45-degree field of view, 2352 by 1568 pixels
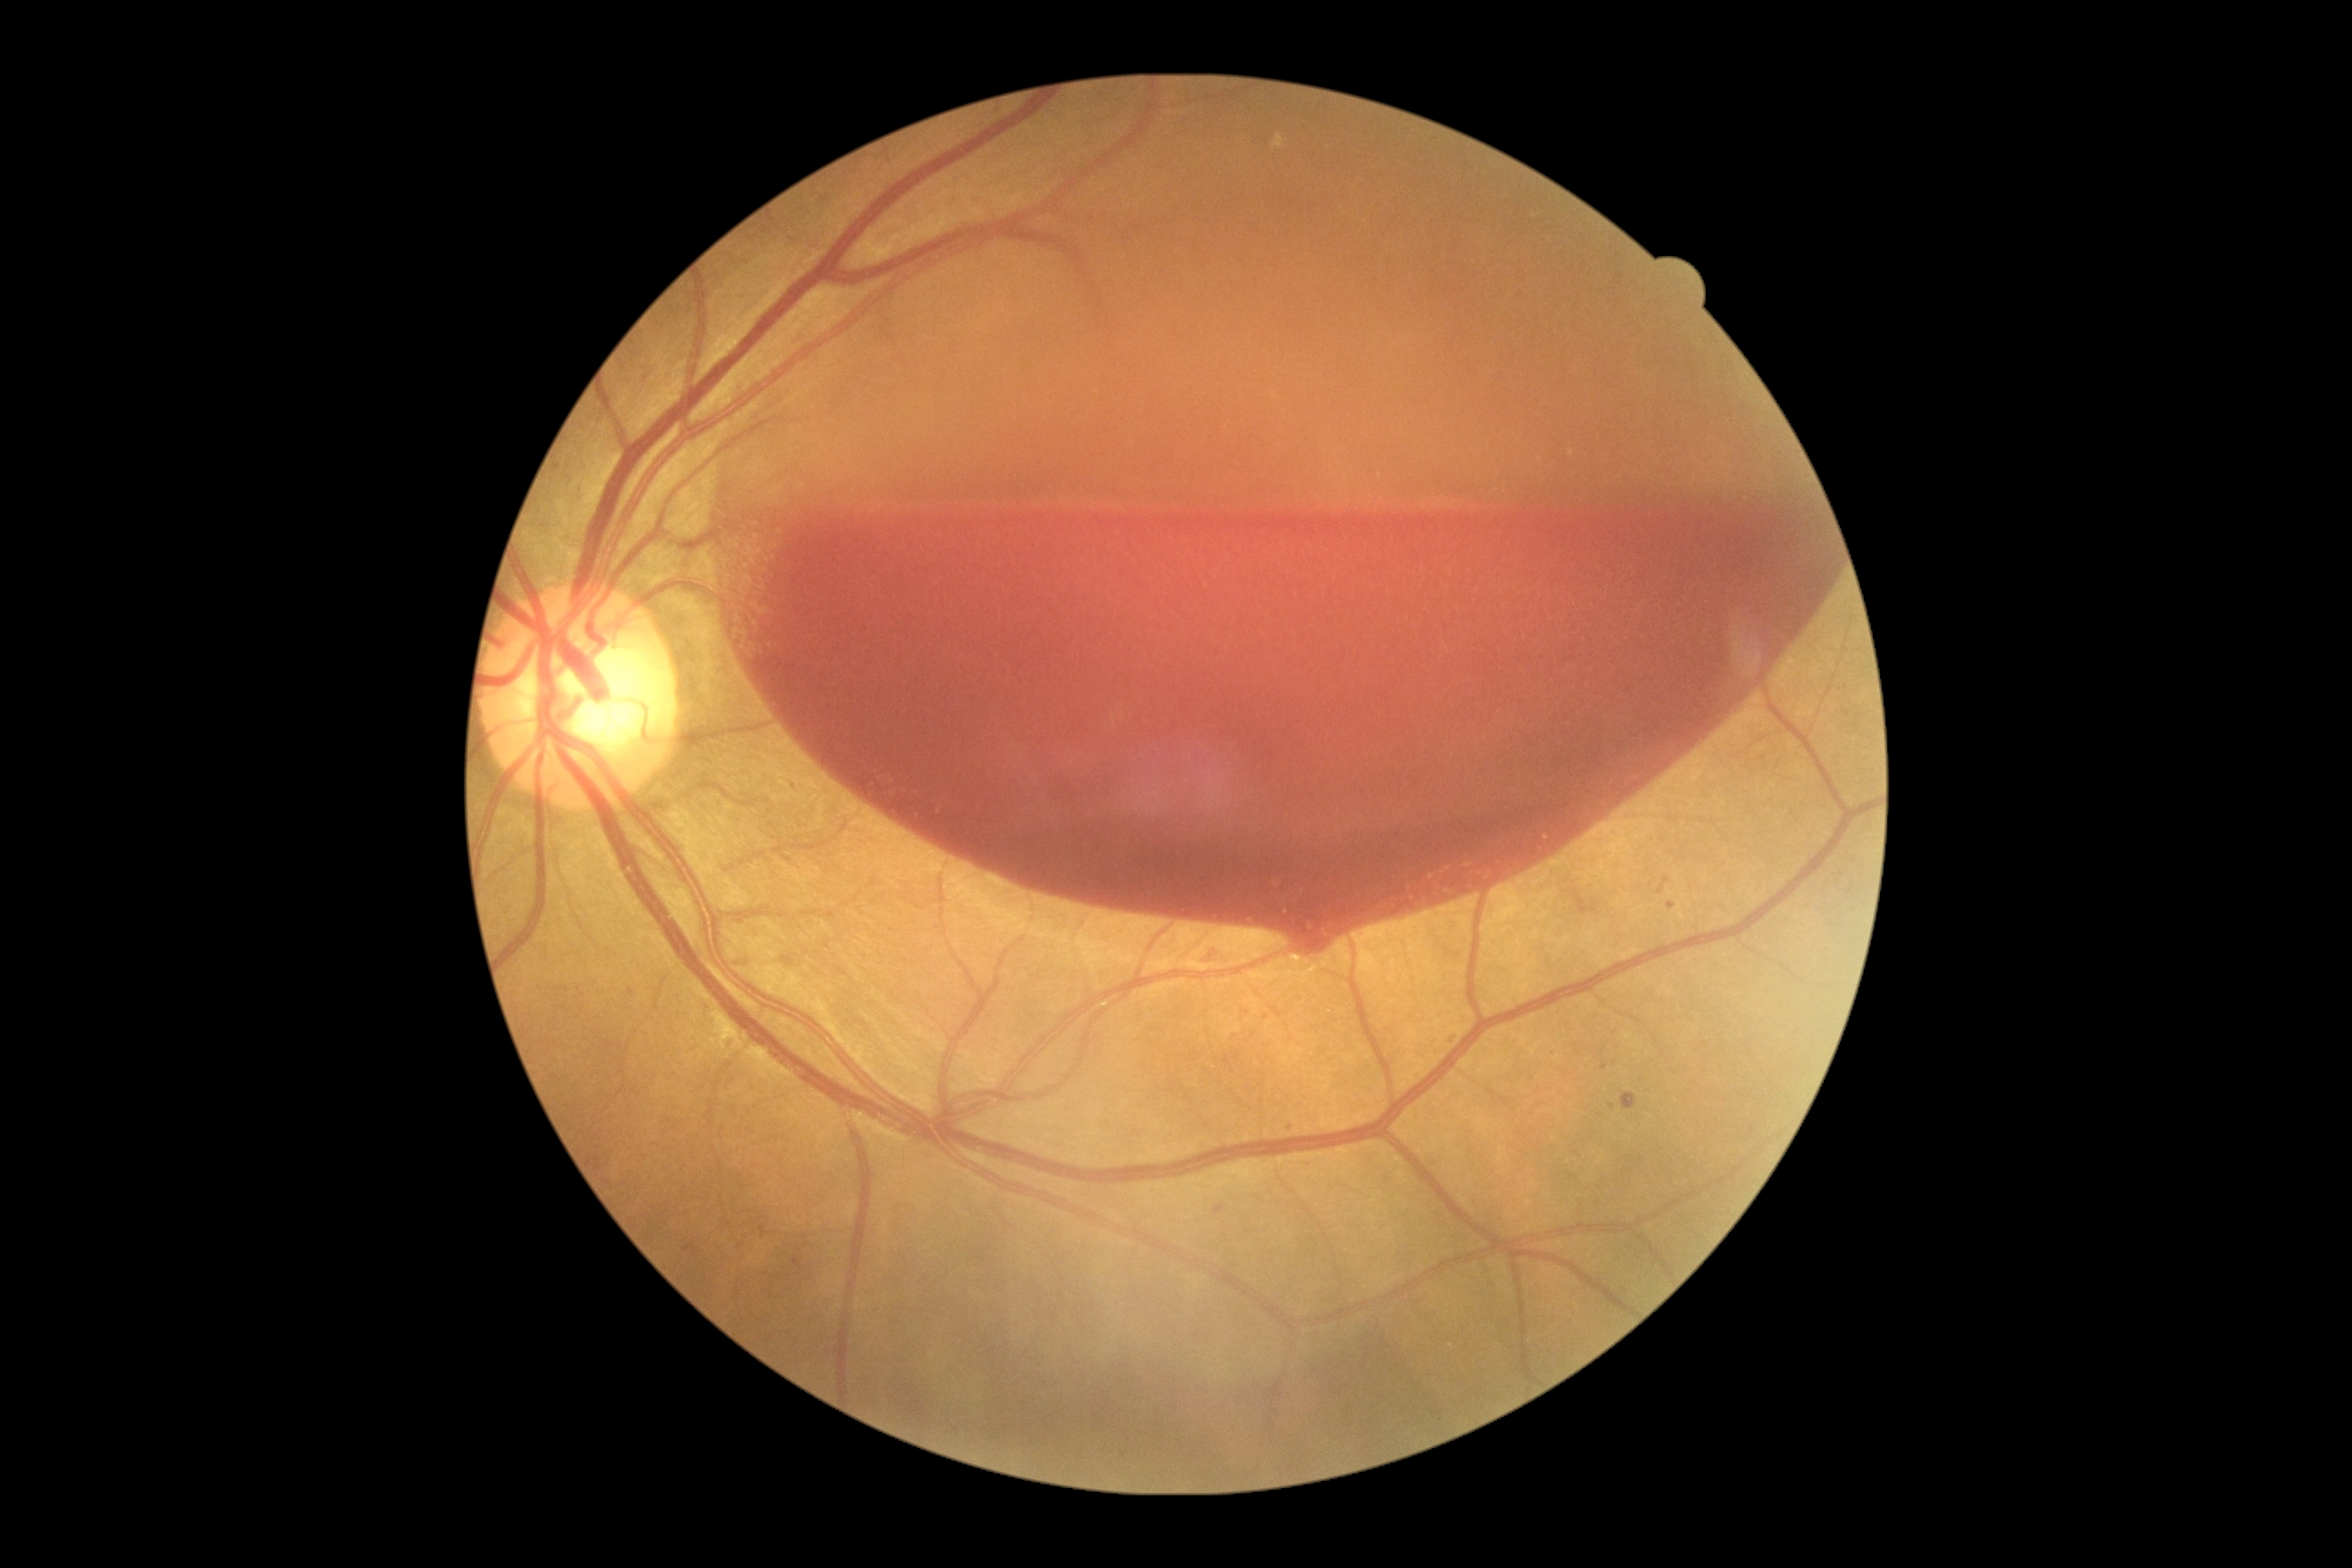 Retinopathy is grade 4 (PDR).